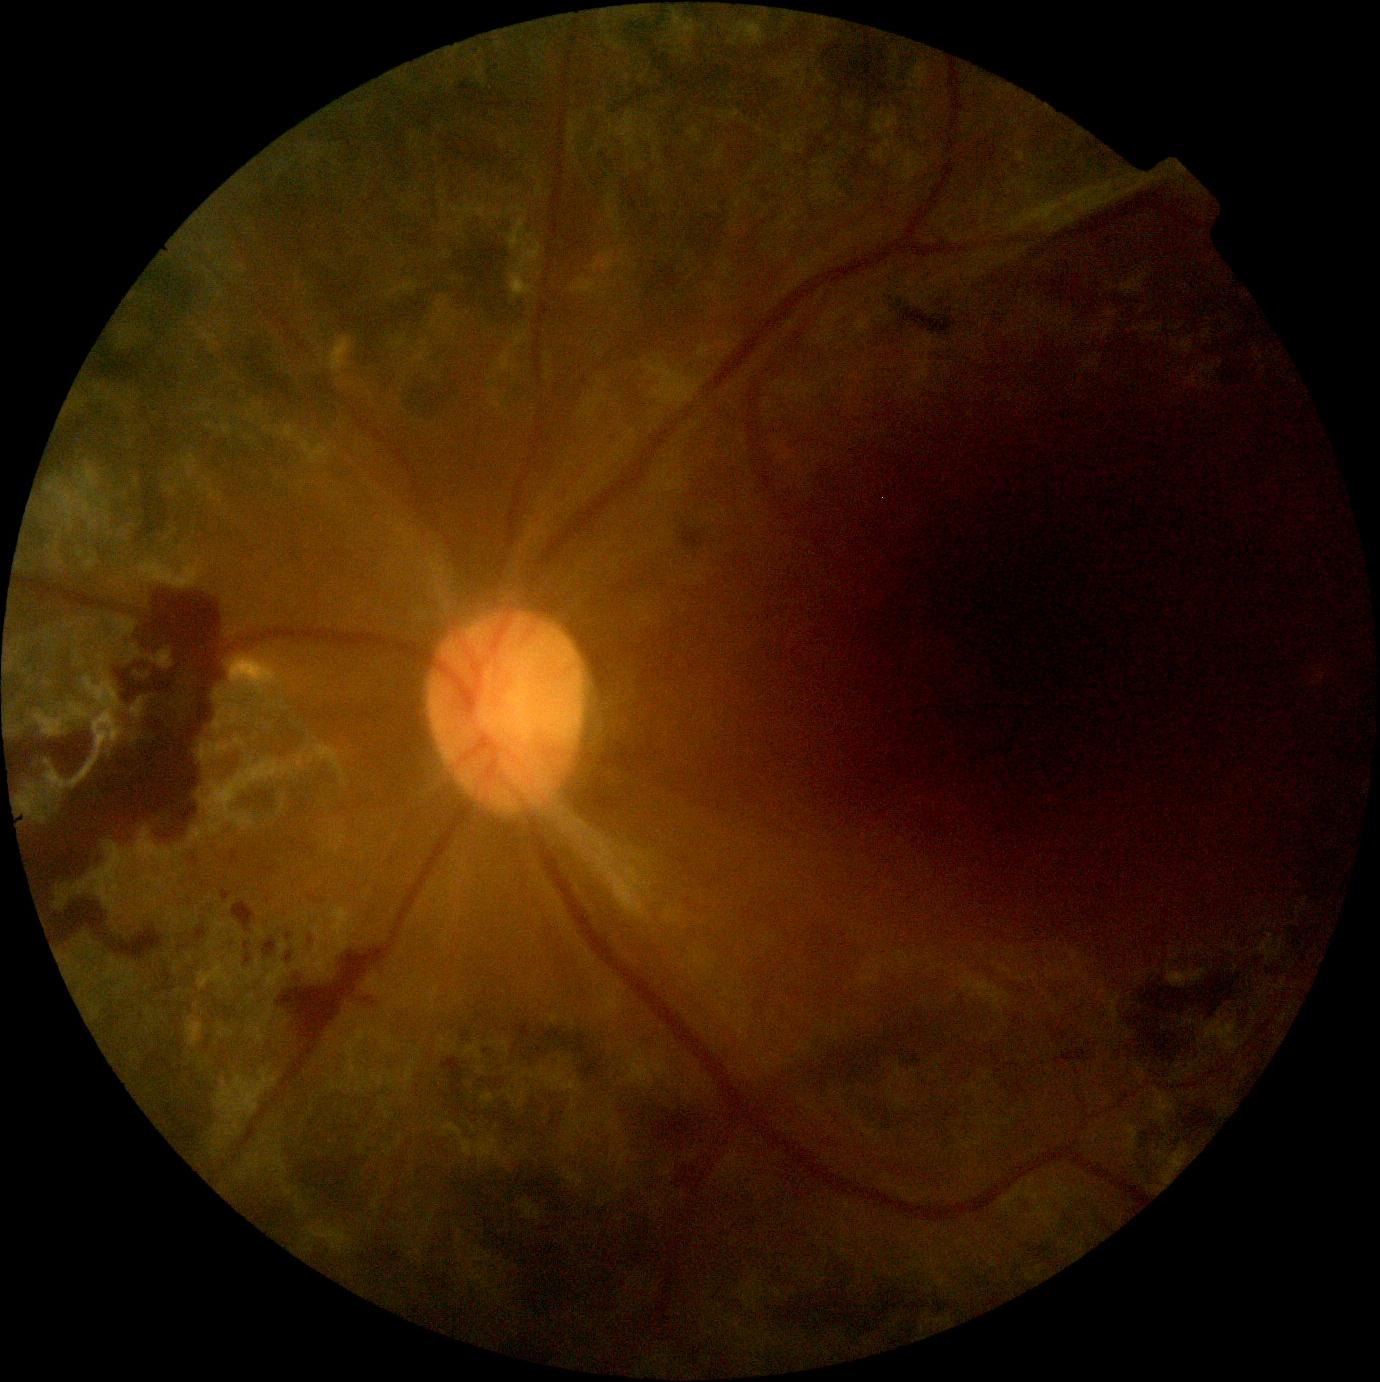

DR severity: grade 4.